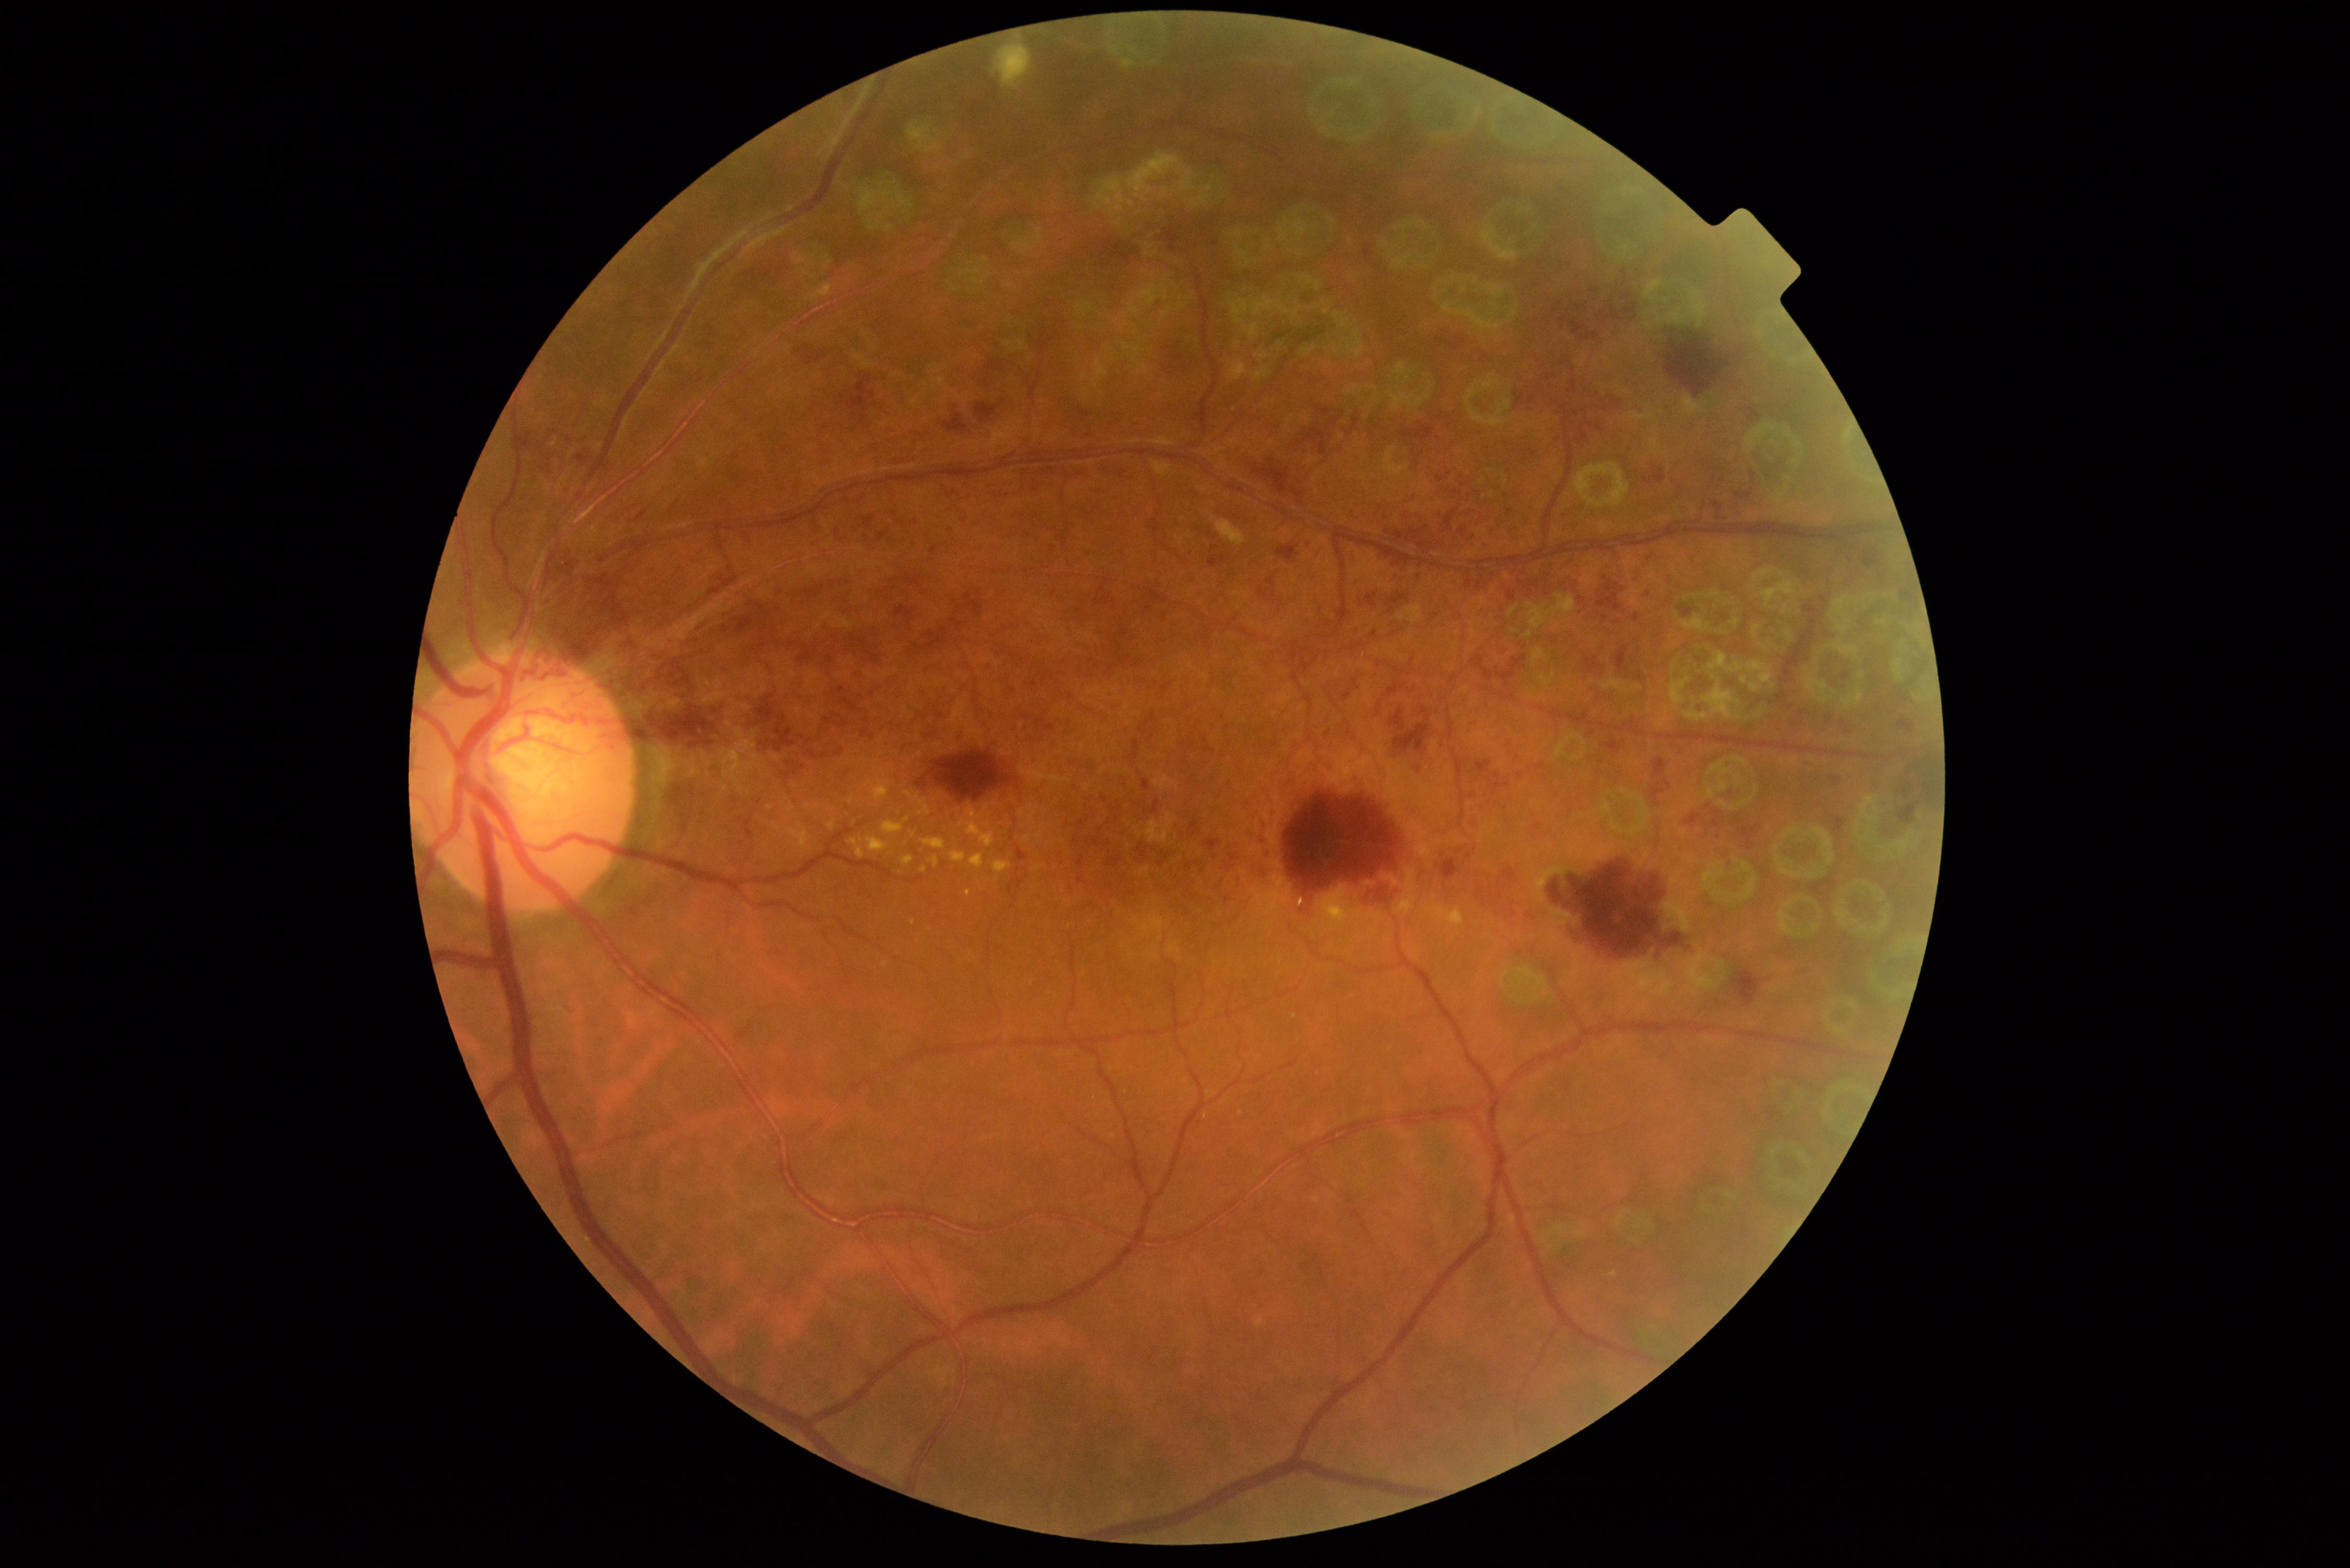
DR: PDR (grade 4).